Nonmydriatic; retinal fundus photograph — 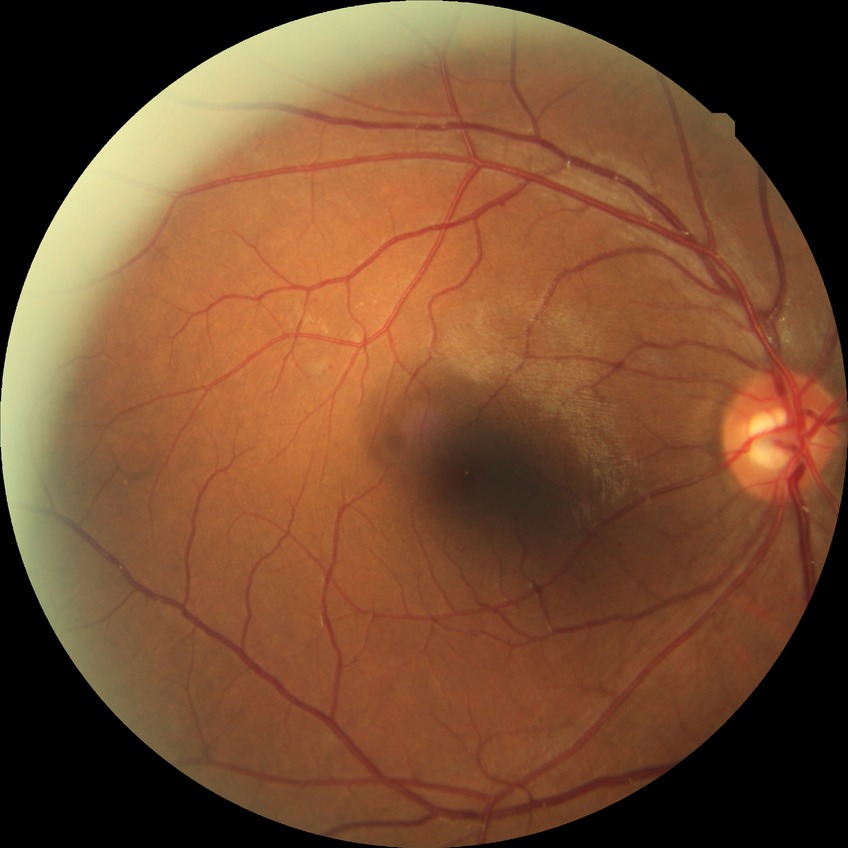 Diabetic retinopathy (DR) is SDR (simple diabetic retinopathy).